Image size 2352x1568:
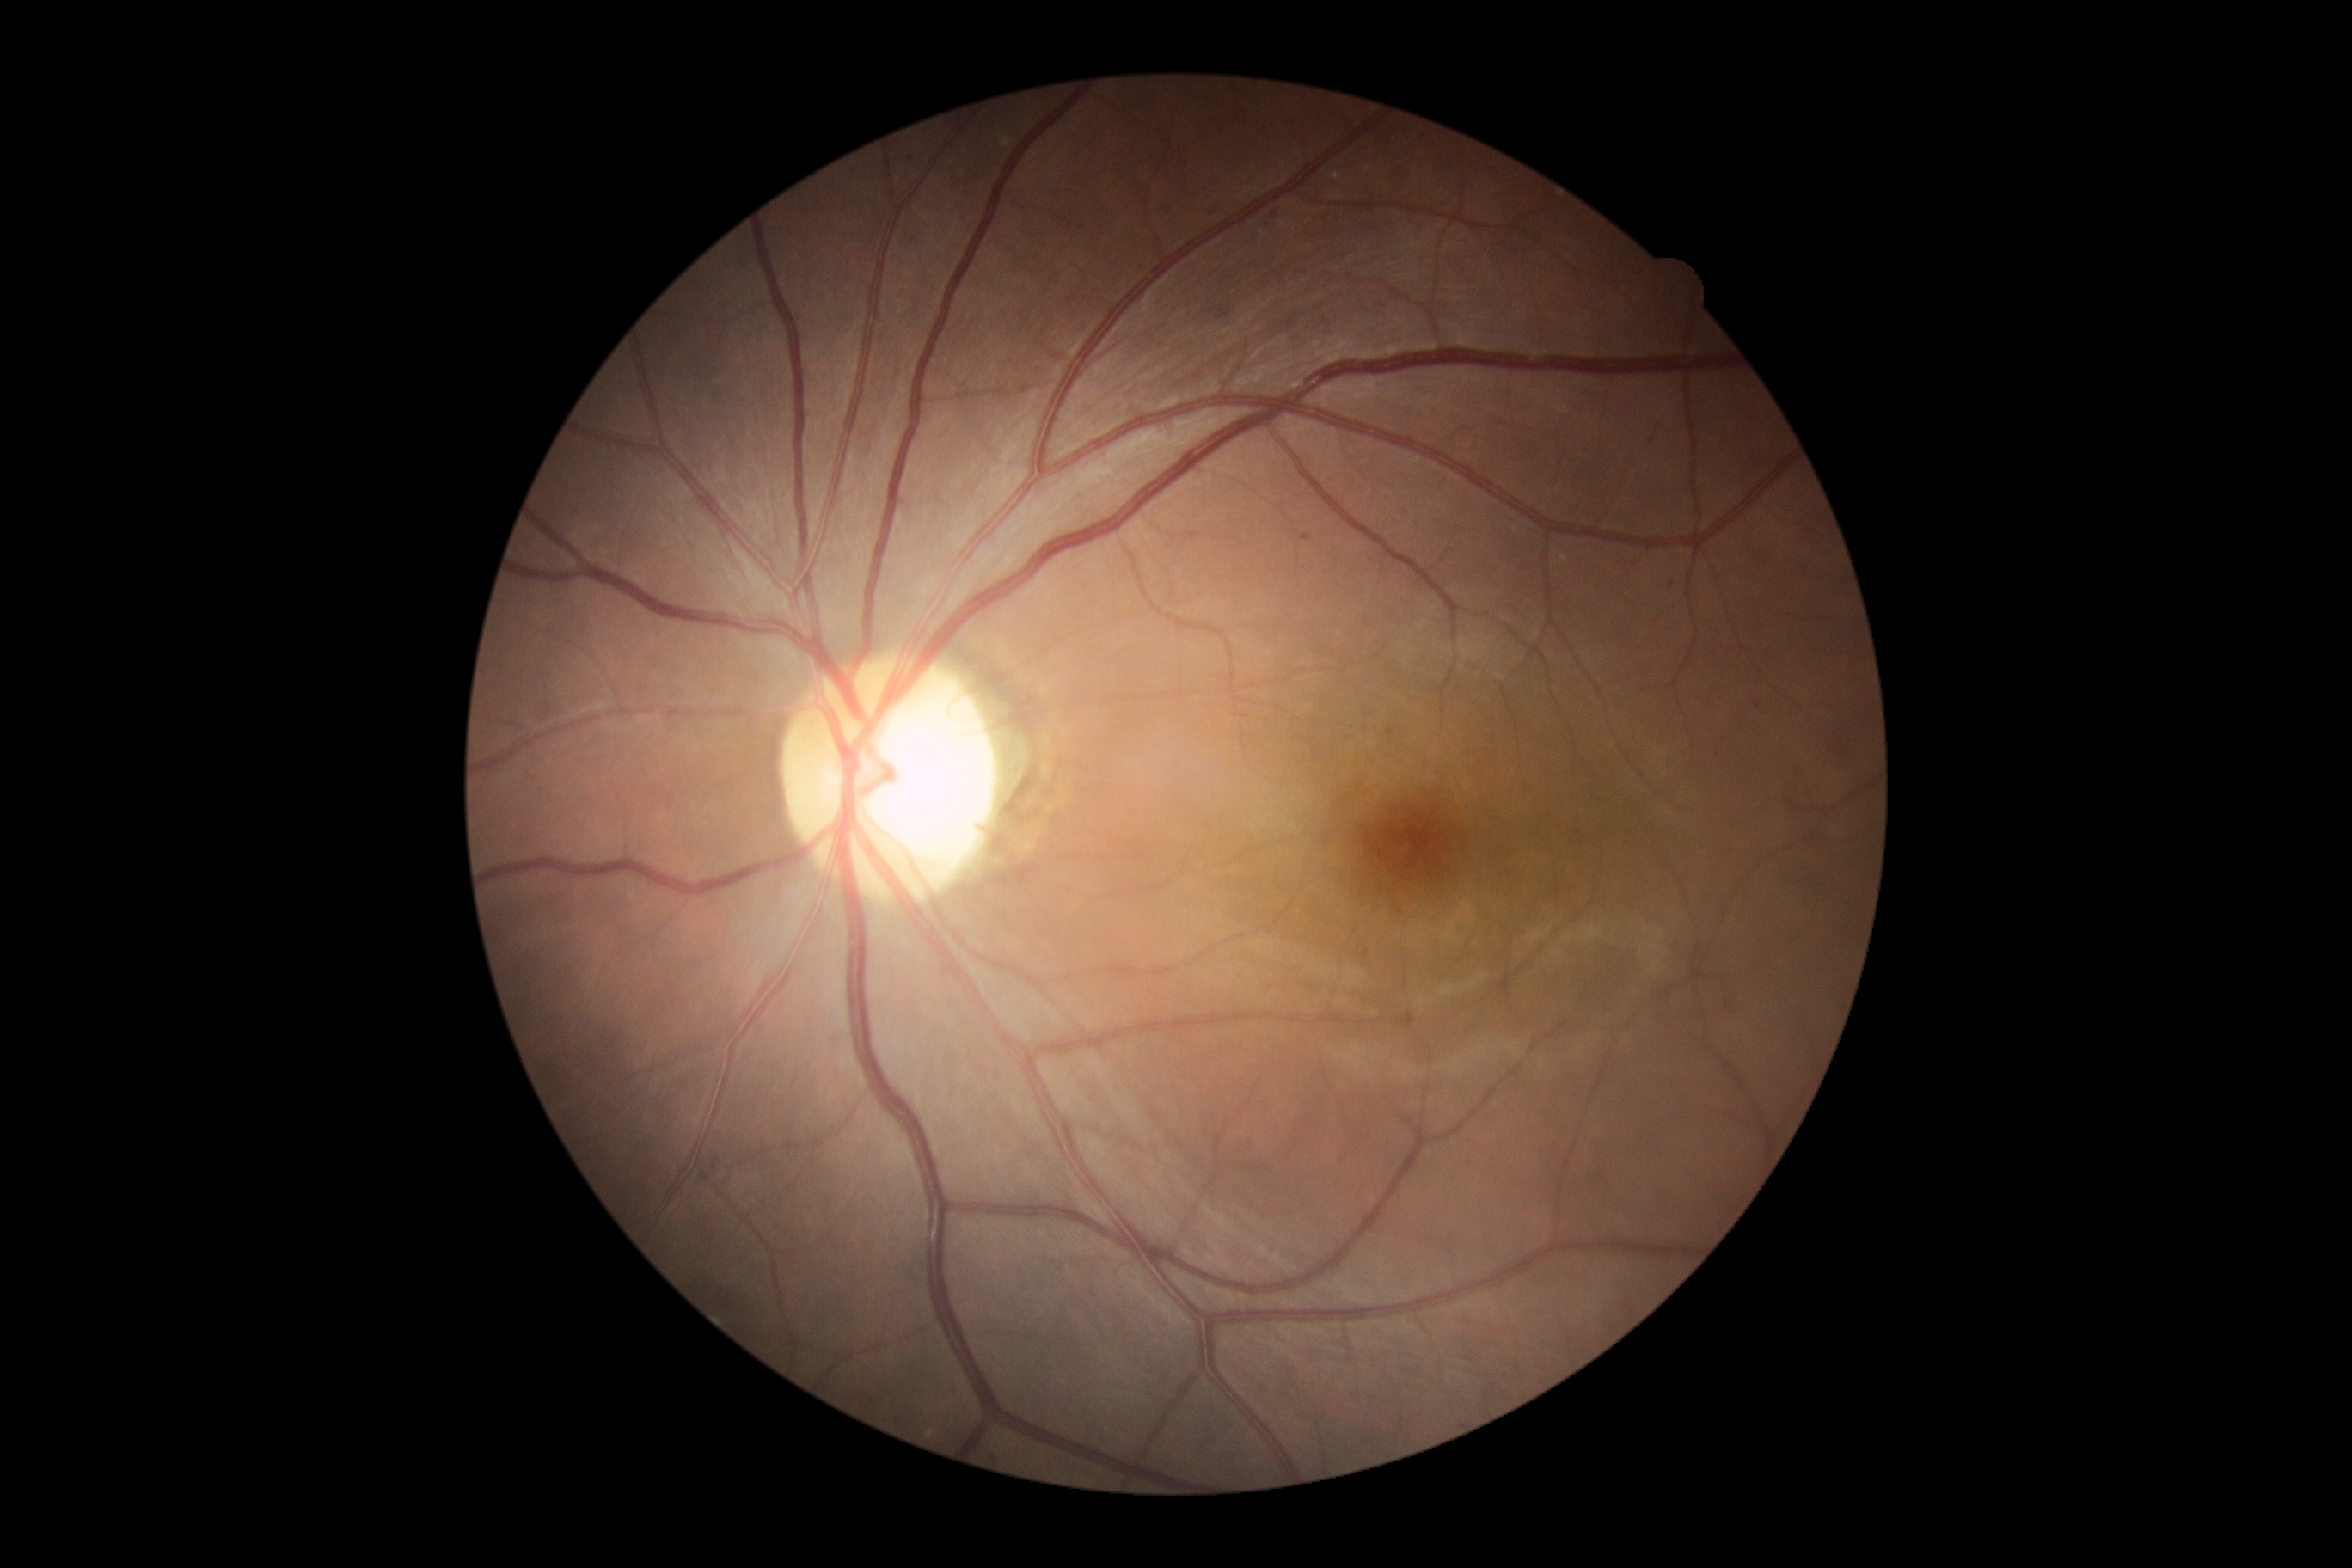
Diabetic retinopathy grade: 1 (mild NPDR)
soft exudates: none
hemorrhages: none
microaneurysms: 1299,534,1309,542 | 1387,728,1395,737
Smaller microaneurysms around 1672/584 | 910/154 | 1213/211 | 1139/266 | 1365/951 | 1275/214 | 899/1420 | 1758/706 | 954/1386
hard exudates: none